Retinal fundus photograph:
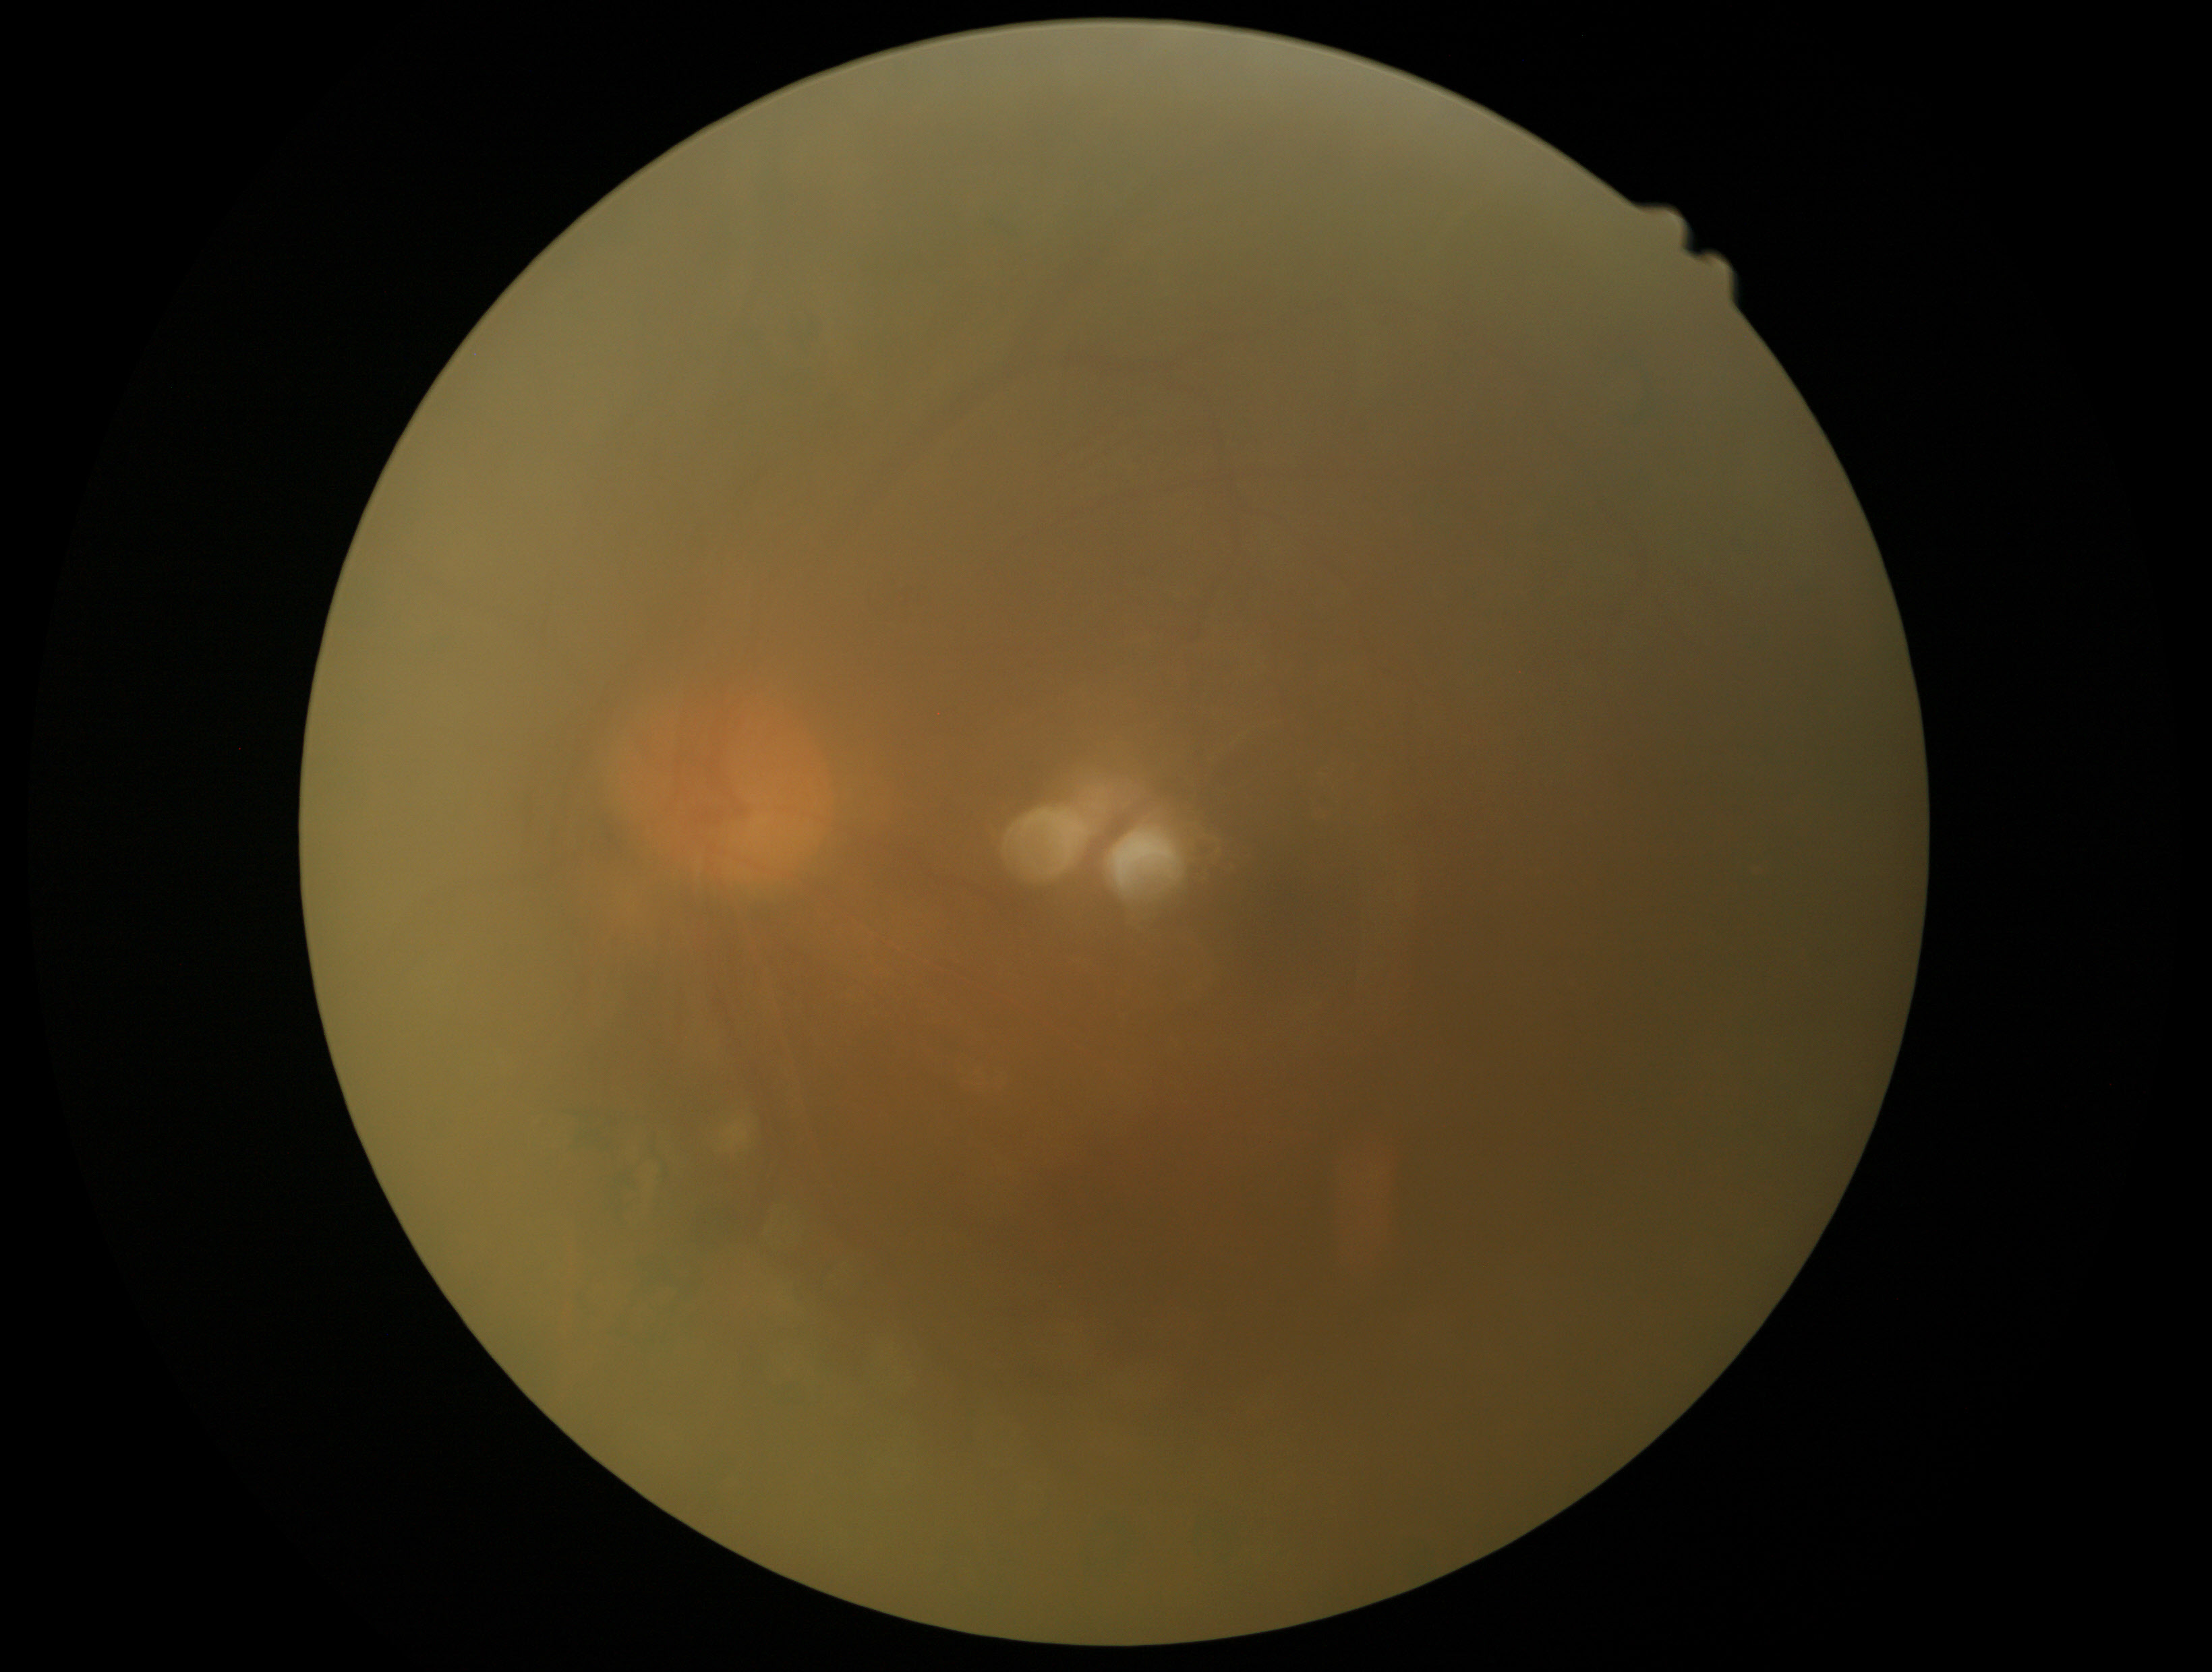 Retinopathy is ungradable due to poor image quality.